Ultra-widefield fundus mosaic: 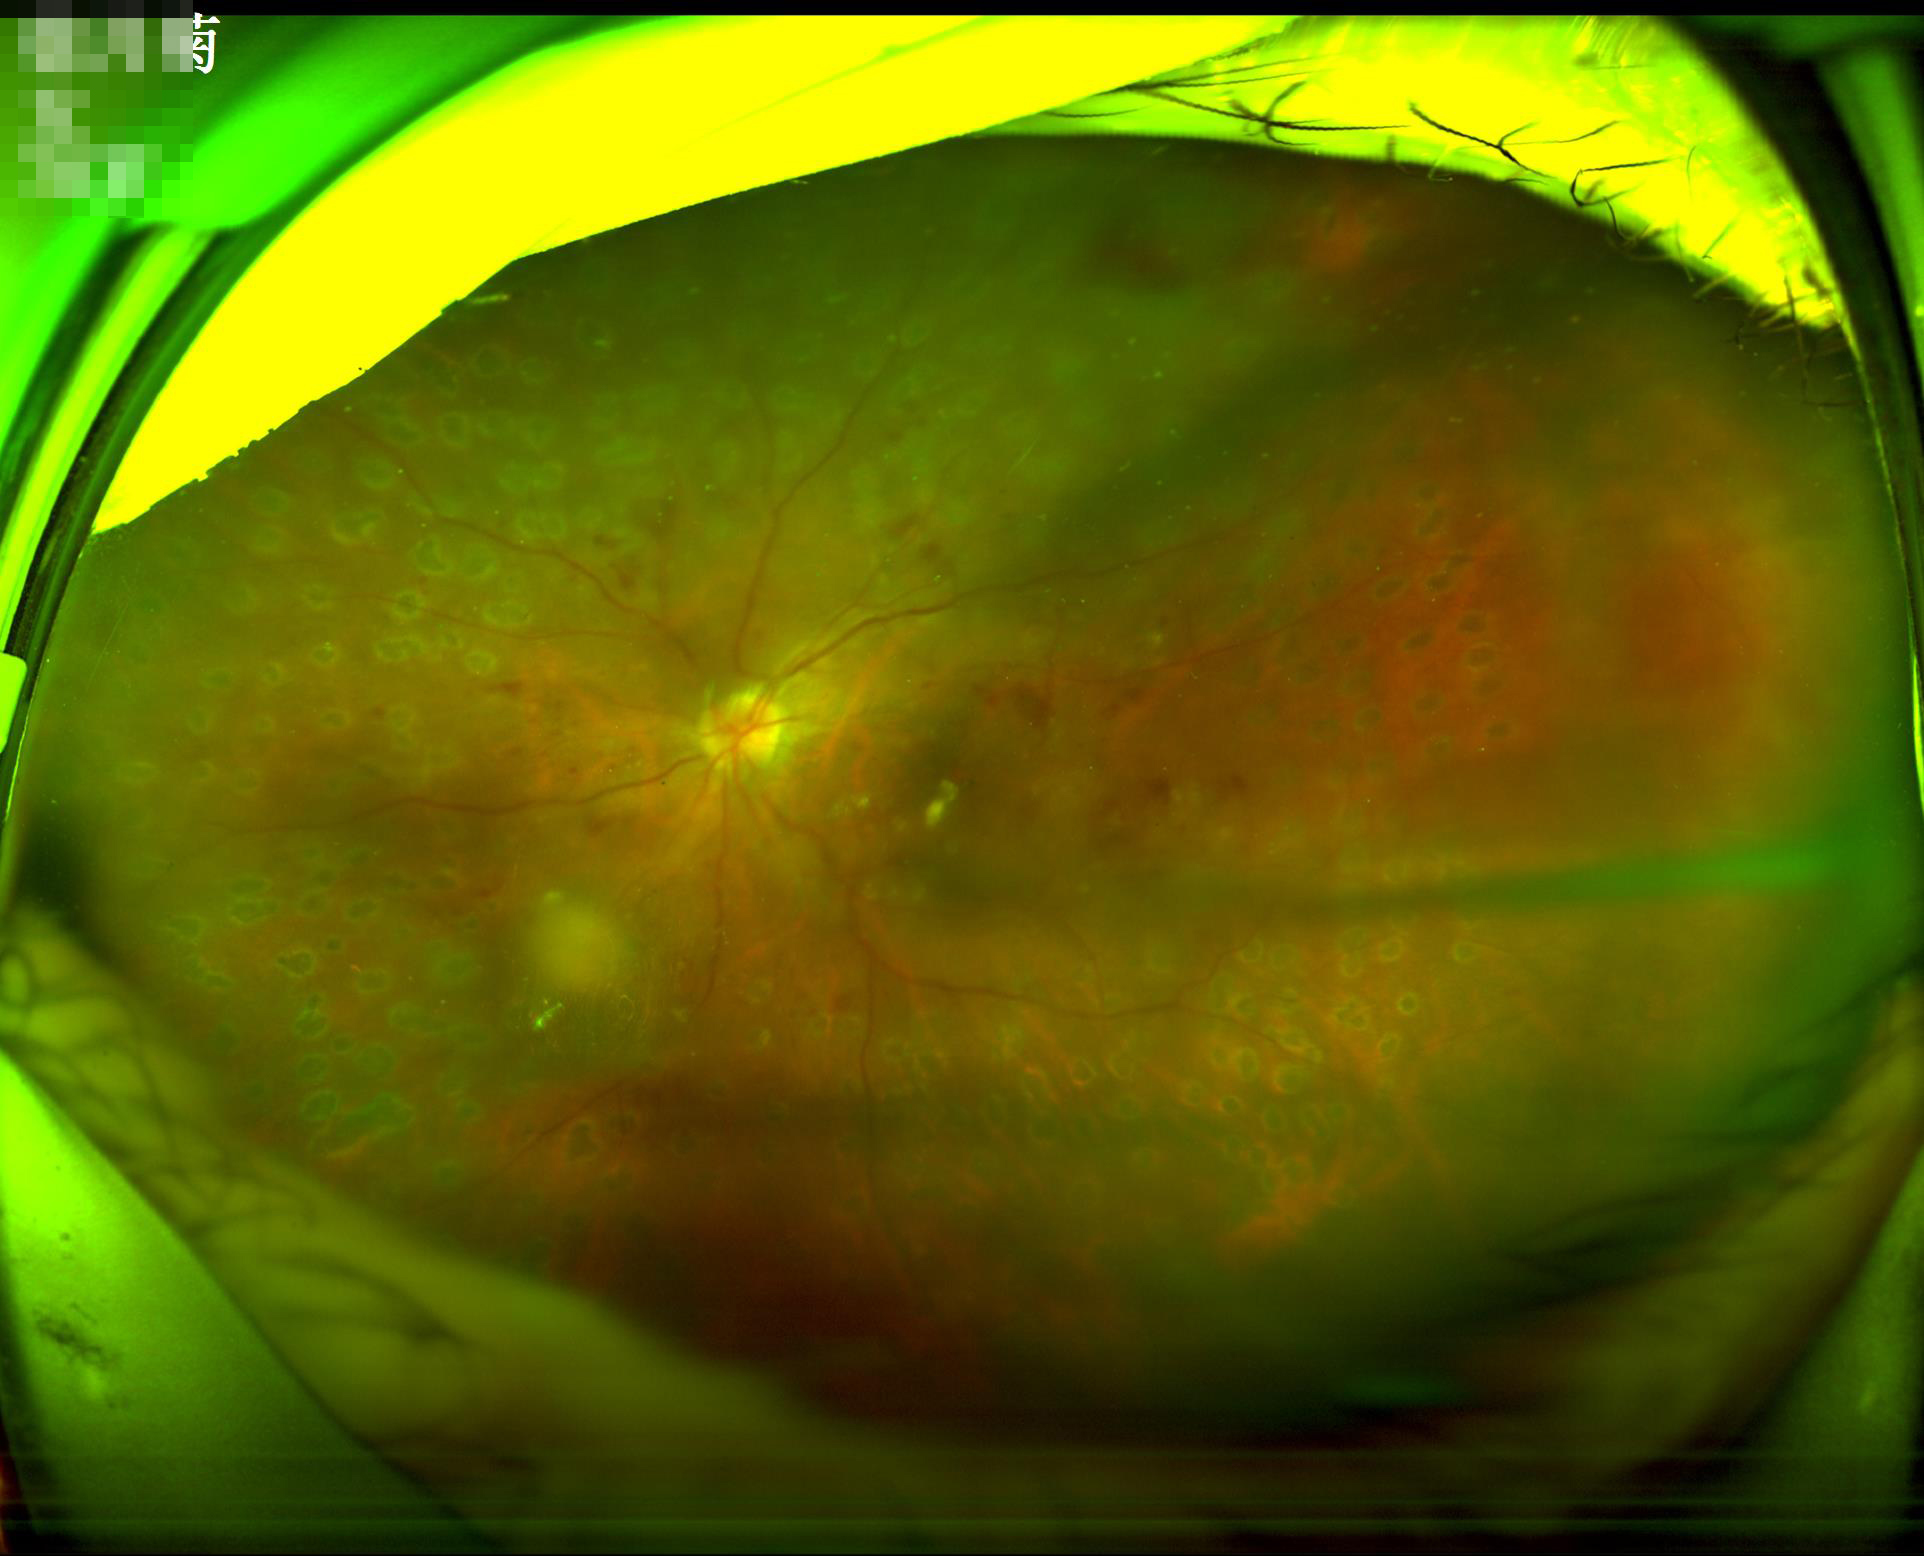 Overall image quality is poor.
Illumination is uneven.
Image is sharp throughout the field.